2352x1568px · 45-degree field of view: 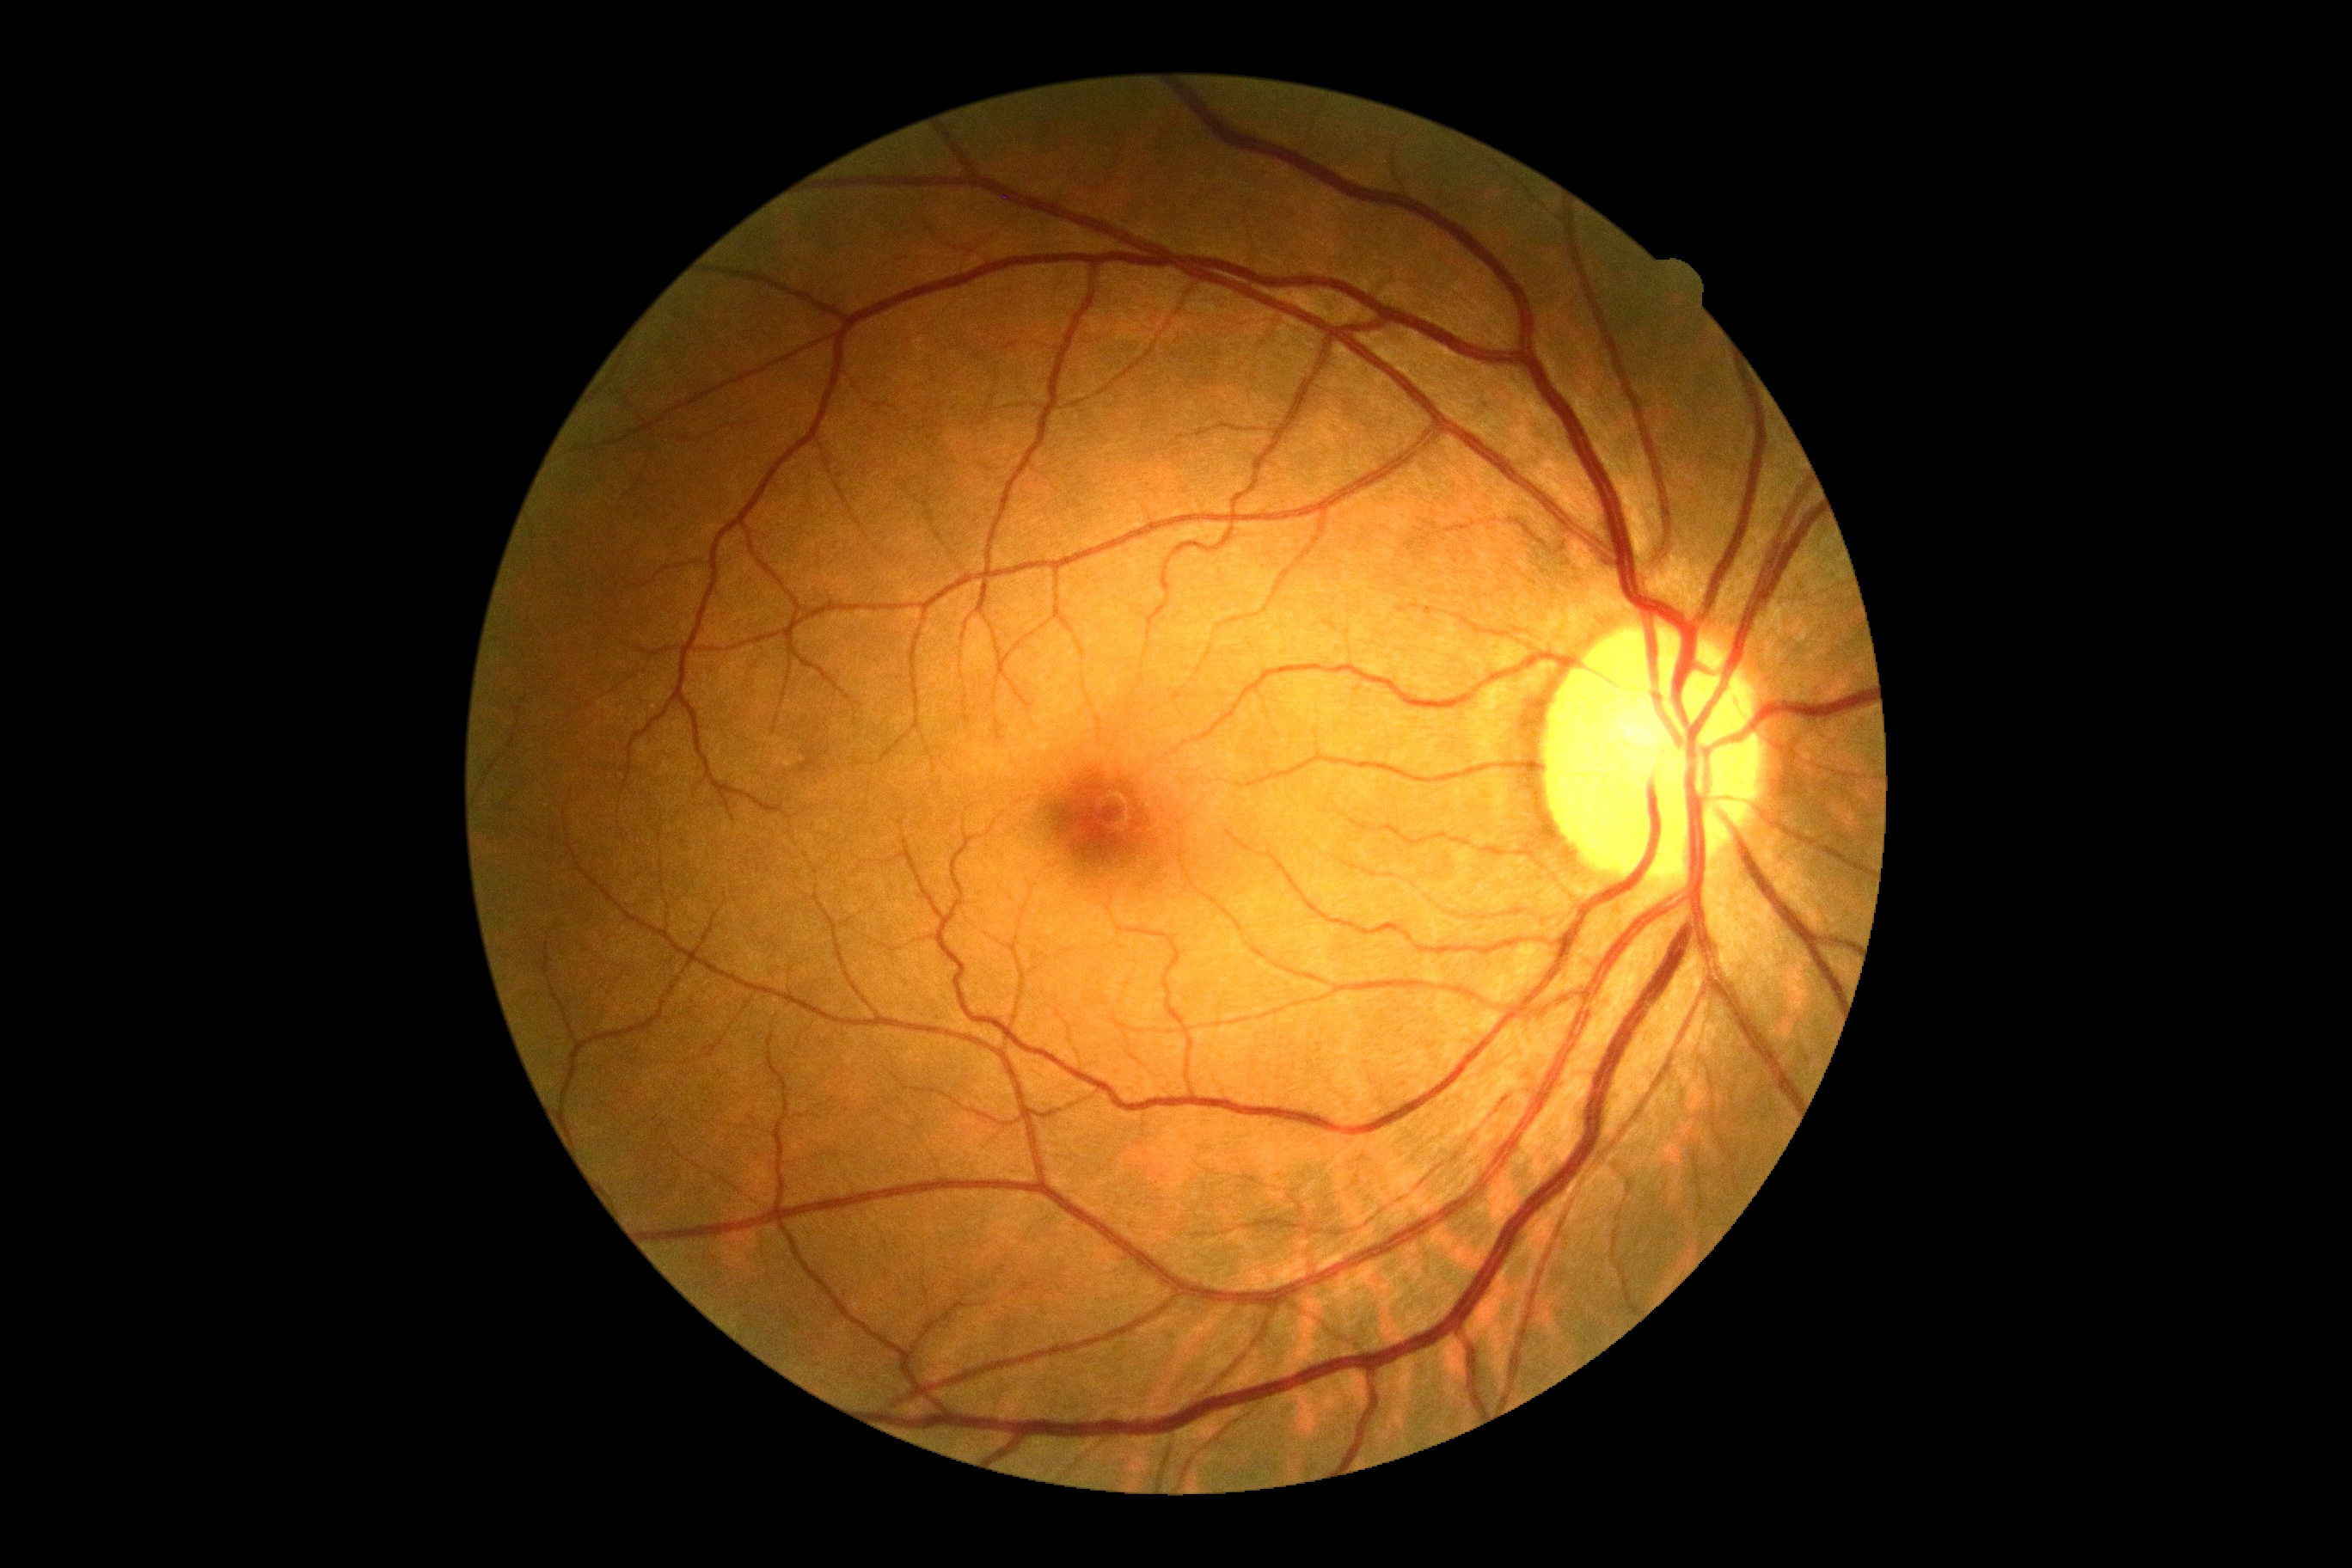

Diabetic retinopathy (DR) is 0/4.
No diabetic retinal disease findings.